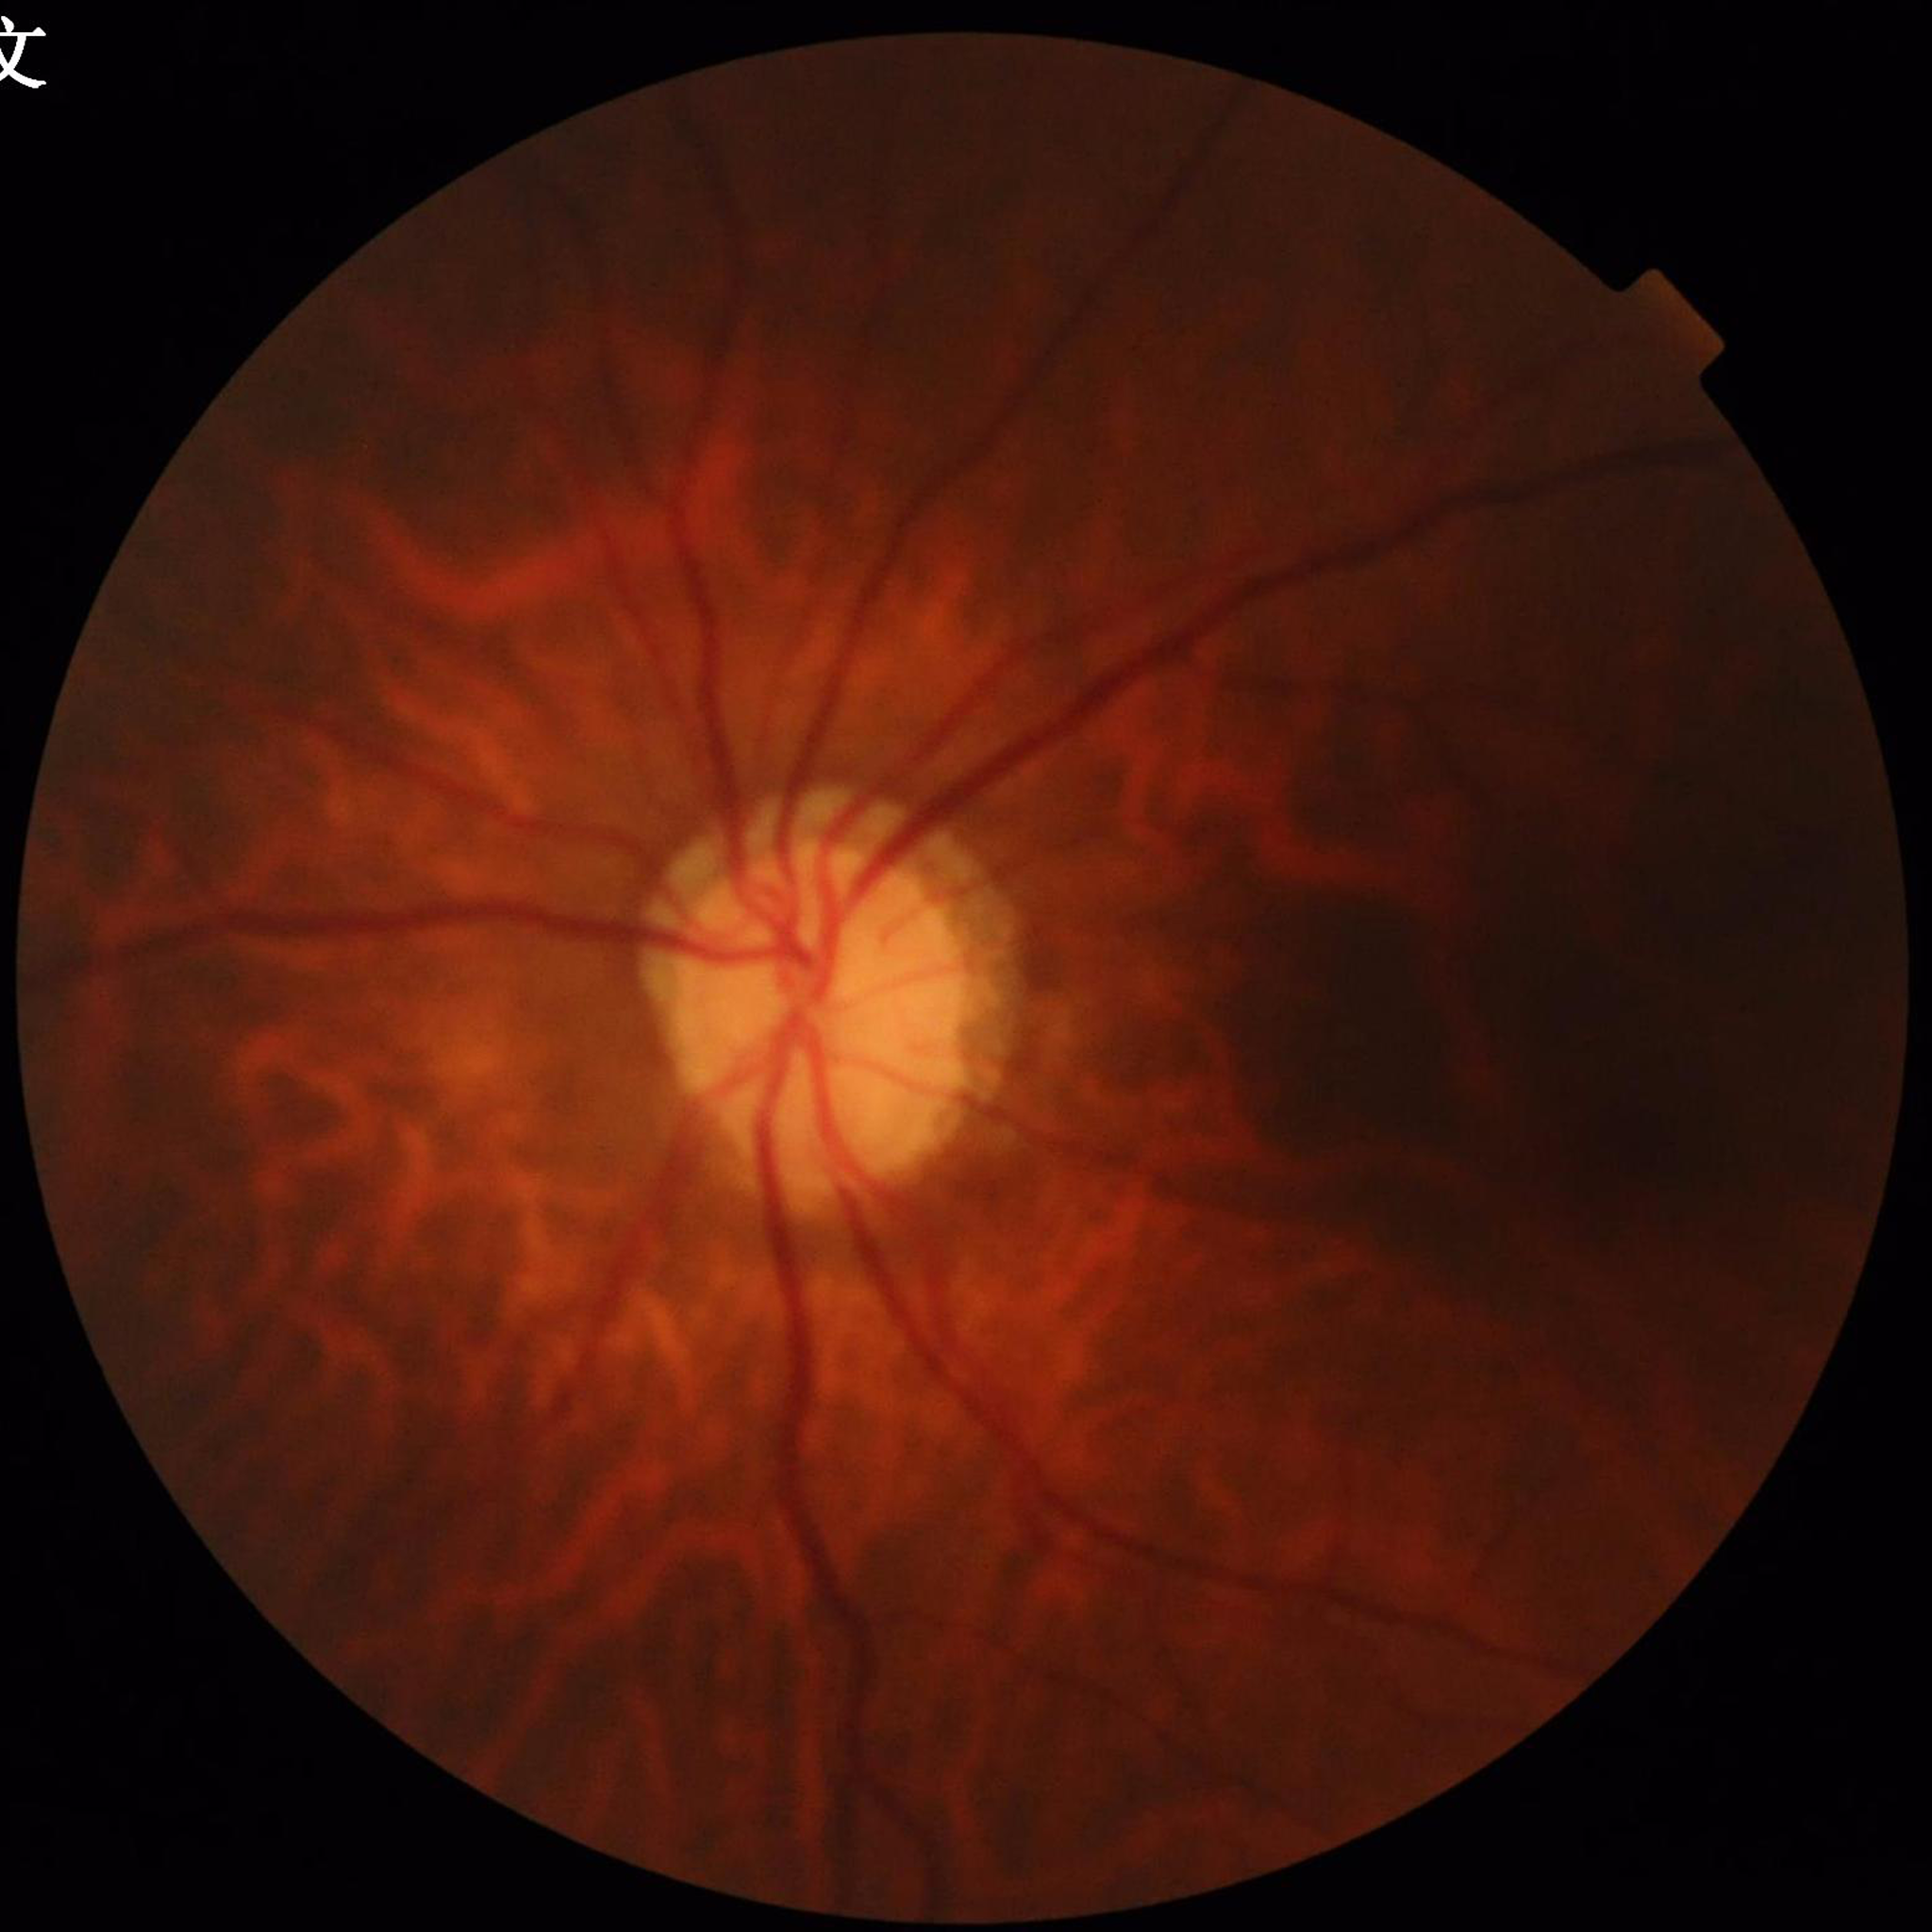 Condition: glaucoma | Image quality: reduced — illumination/color distortion.